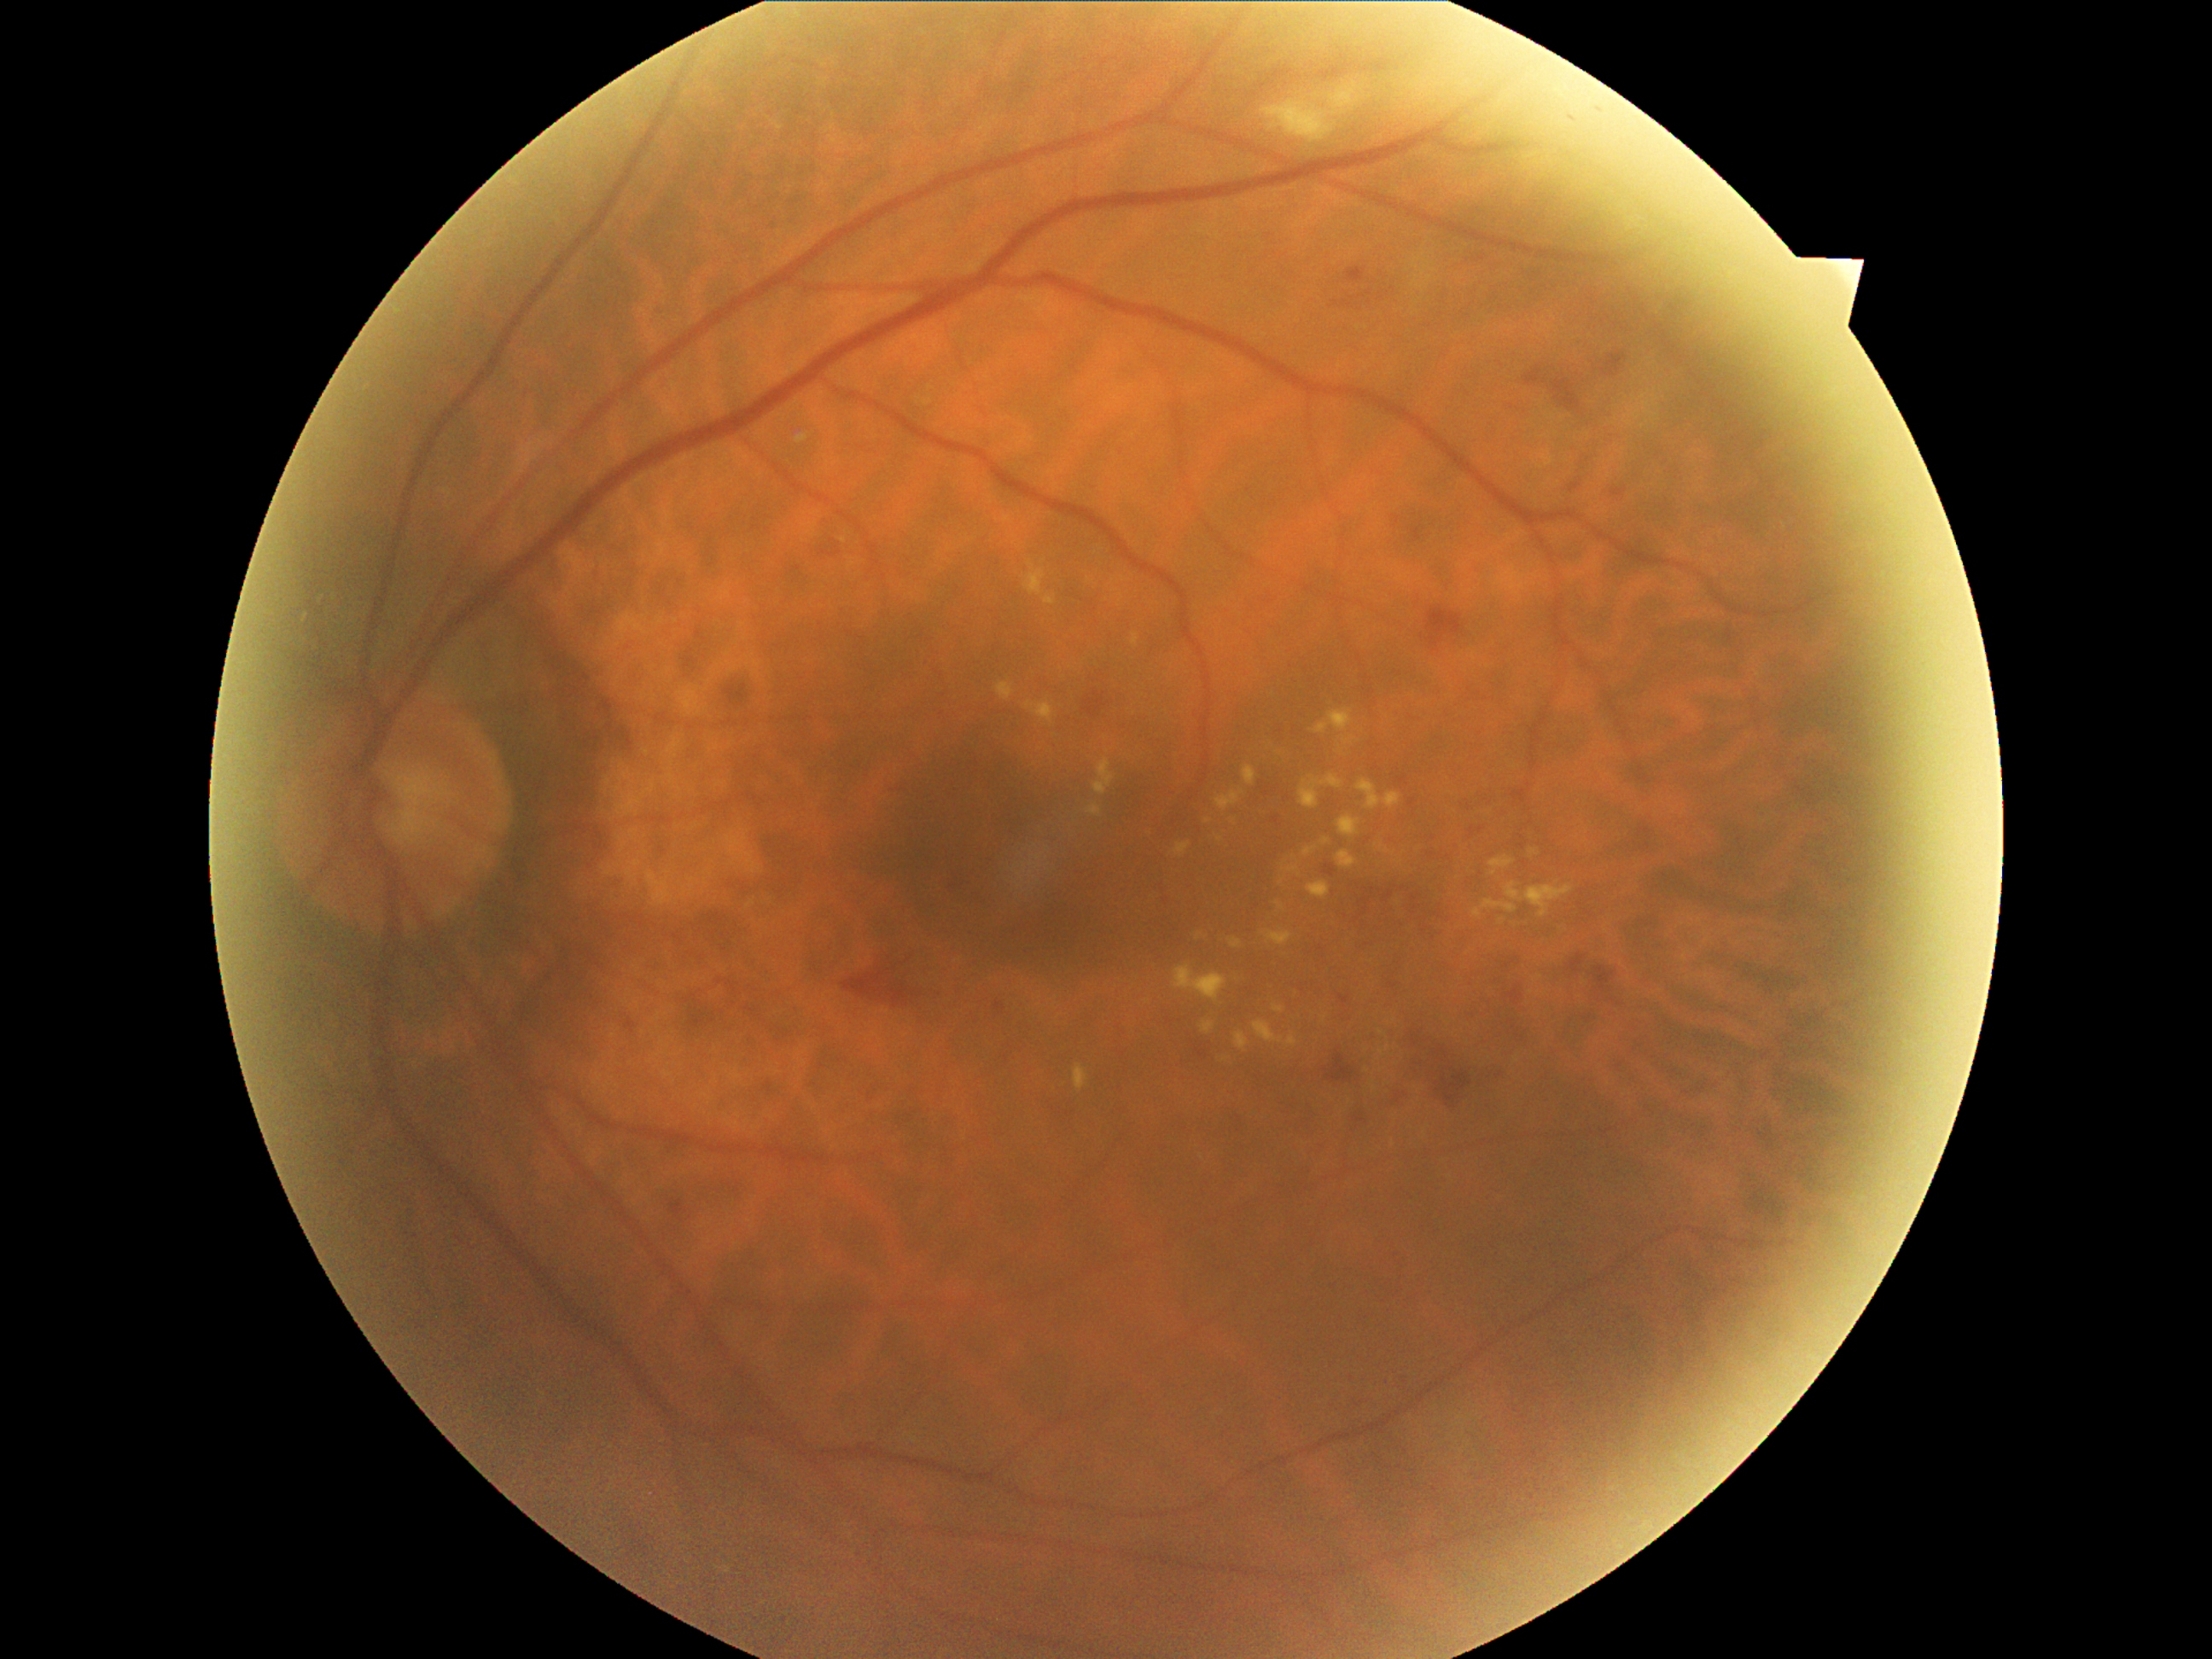 Diabetic retinopathy (DR) is grade 2. Hard exudates (EXs) include lesions at l=1305, t=846, r=1318, b=856; l=998, t=682, r=1015, b=701; l=1175, t=842, r=1192, b=856; l=1300, t=774, r=1344, b=810; l=1380, t=1045, r=1390, b=1056; l=1308, t=882, r=1330, b=899; l=1132, t=634, r=1139, b=644; l=1093, t=759, r=1117, b=795; l=1337, t=815, r=1363, b=839; l=1025, t=562, r=1047, b=595; l=1088, t=805, r=1102, b=817. Small EXs approximately at (1199, 938); (1383, 1033); (1208, 821).